848 by 848 pixels; Davis DR grading:
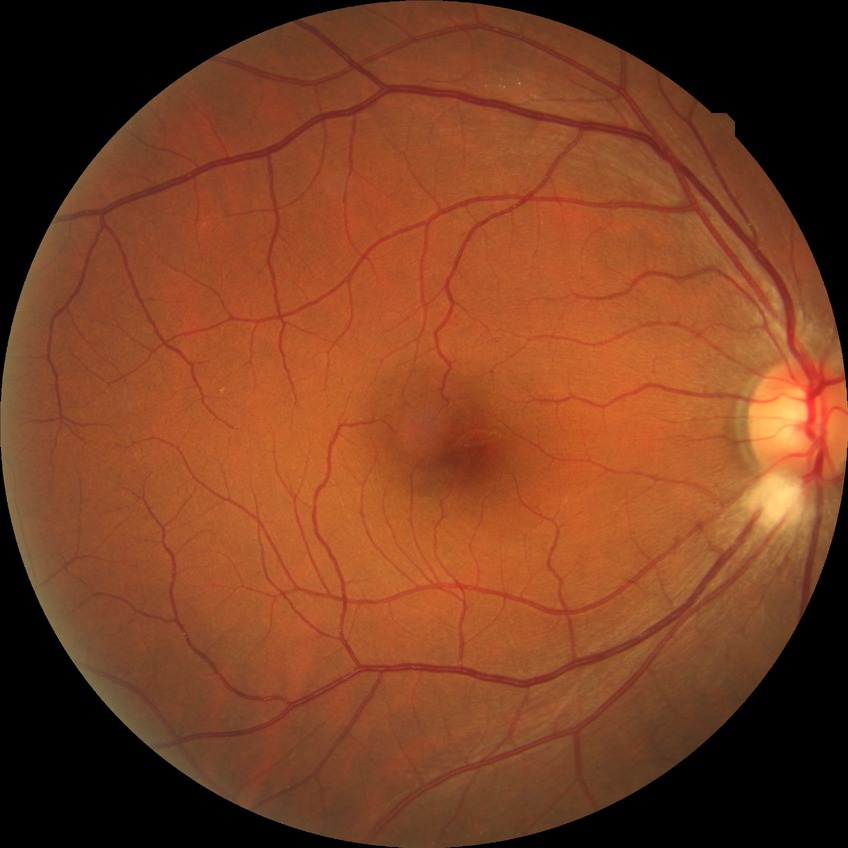

DR stage: NDR.